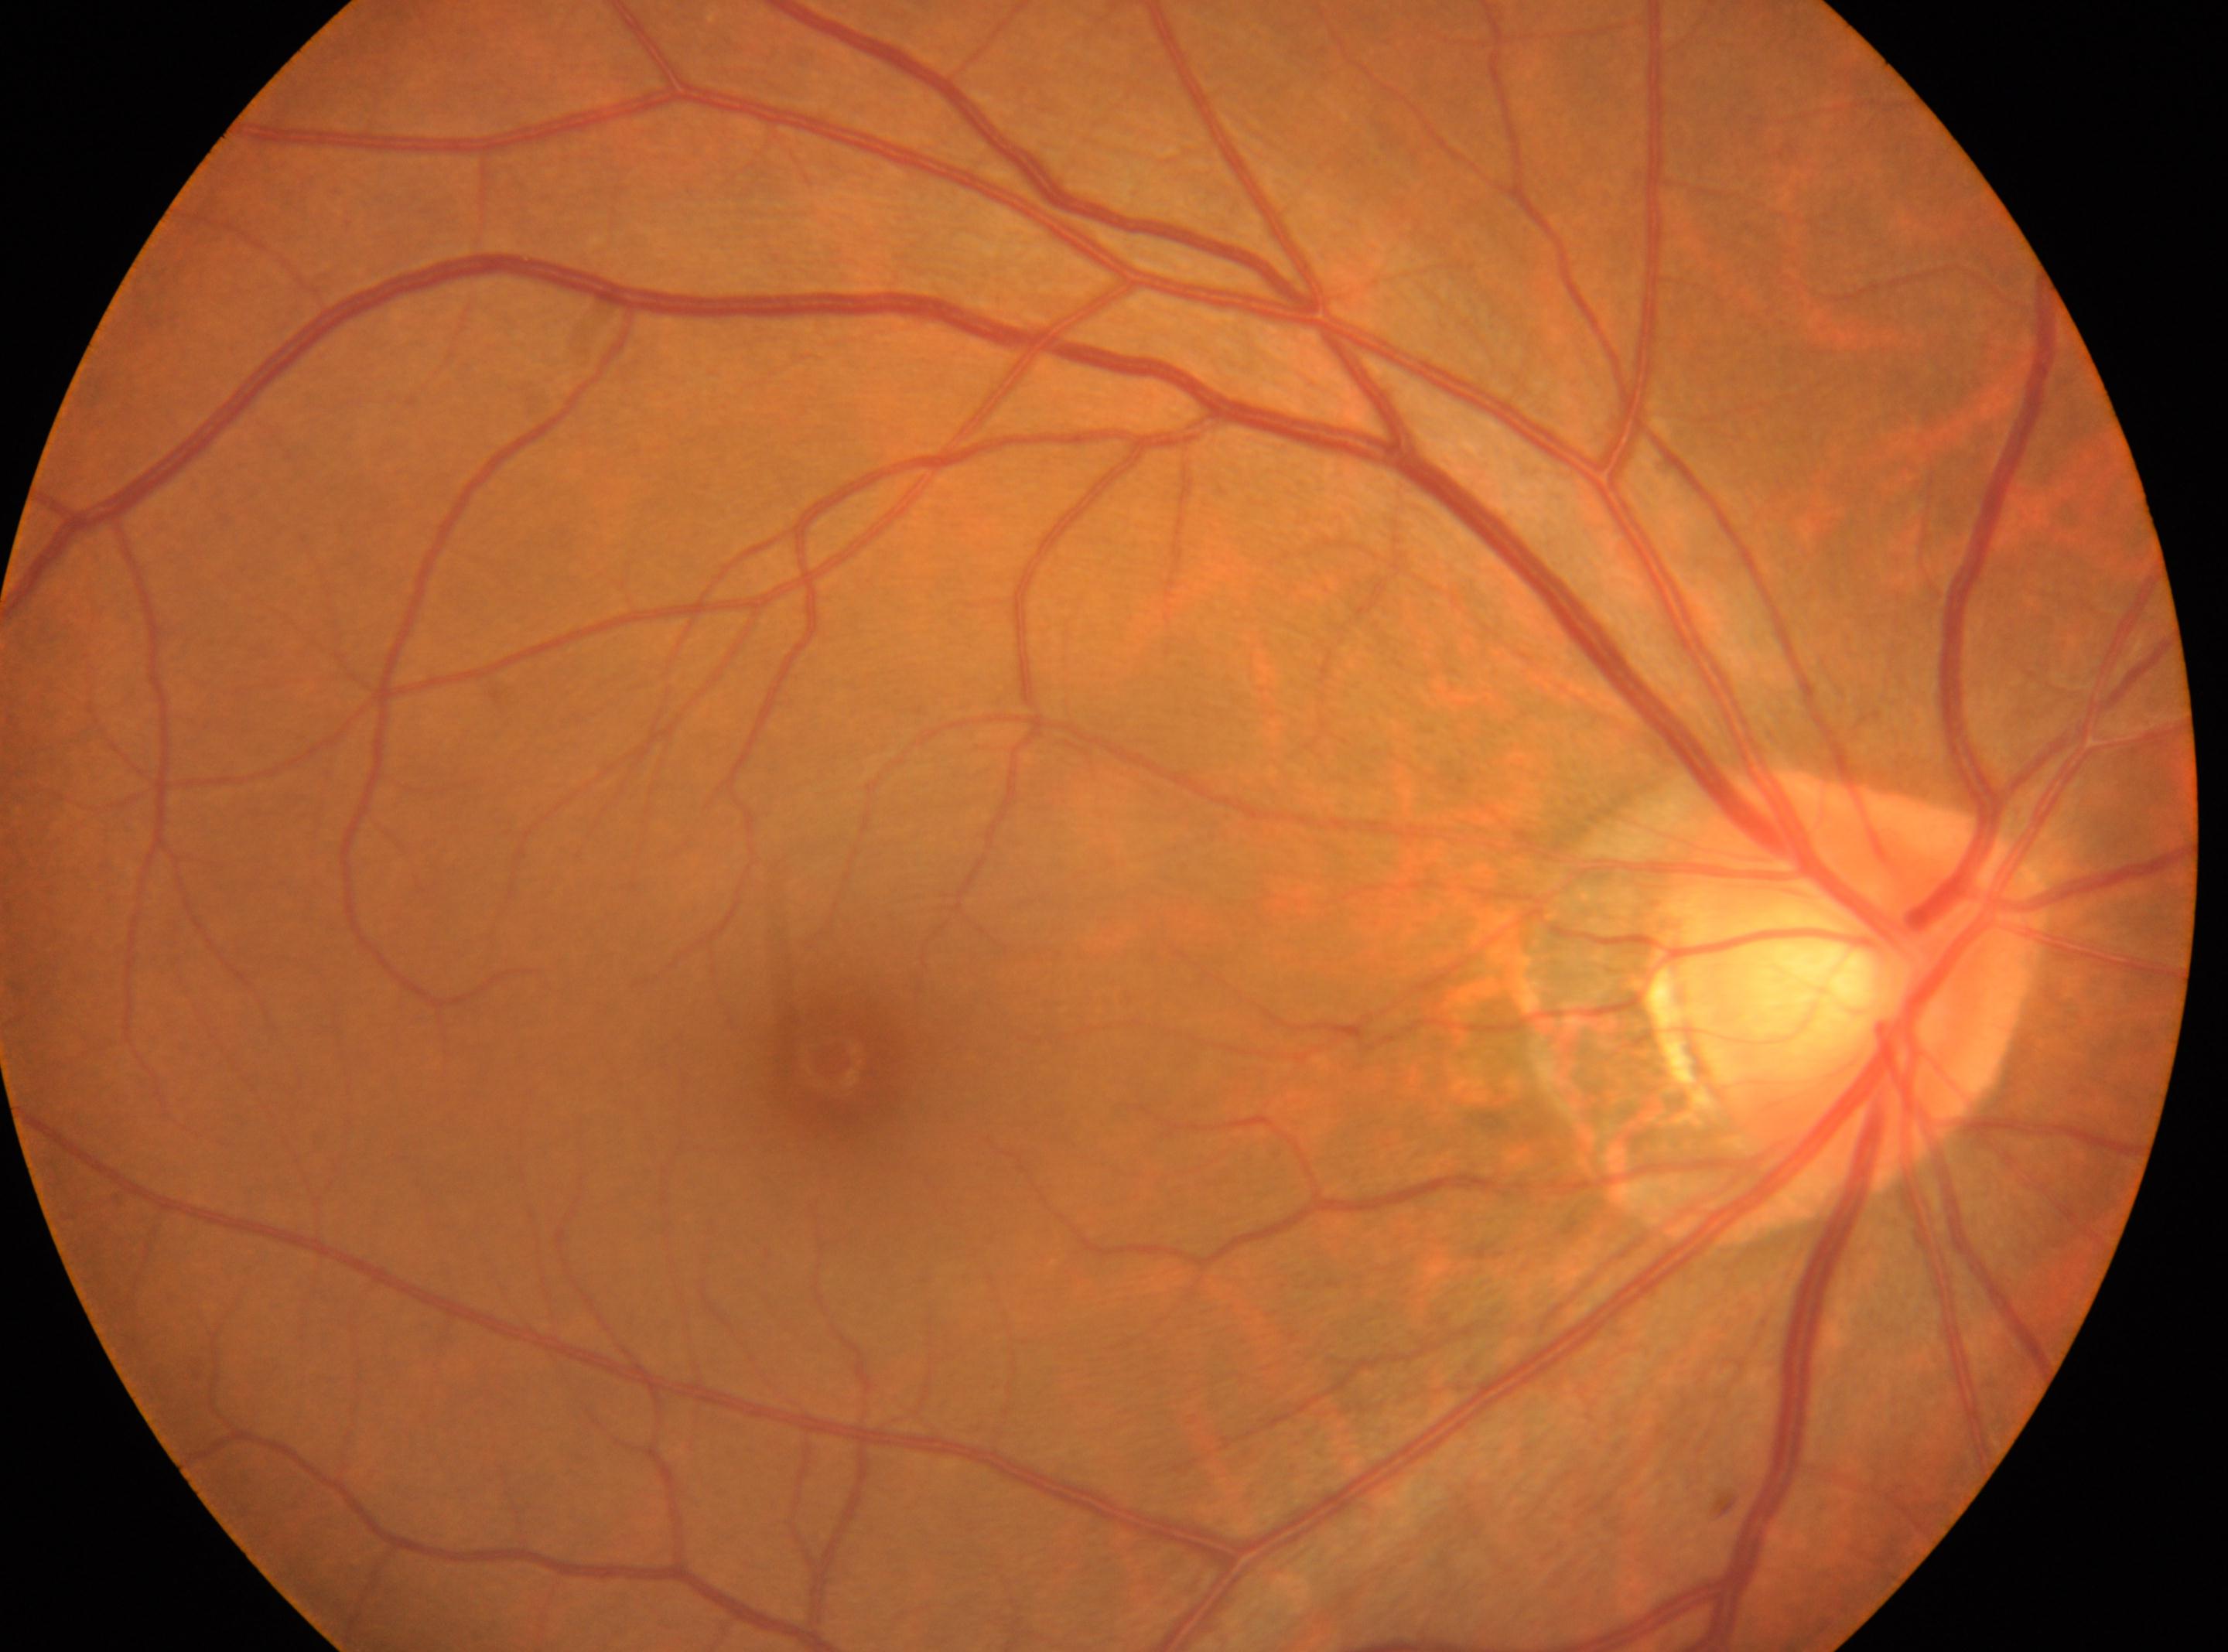
macular center: 829, 1060; diabetic retinopathy (DR): 0; laterality: right eye; optic nerve head: 1861, 978.